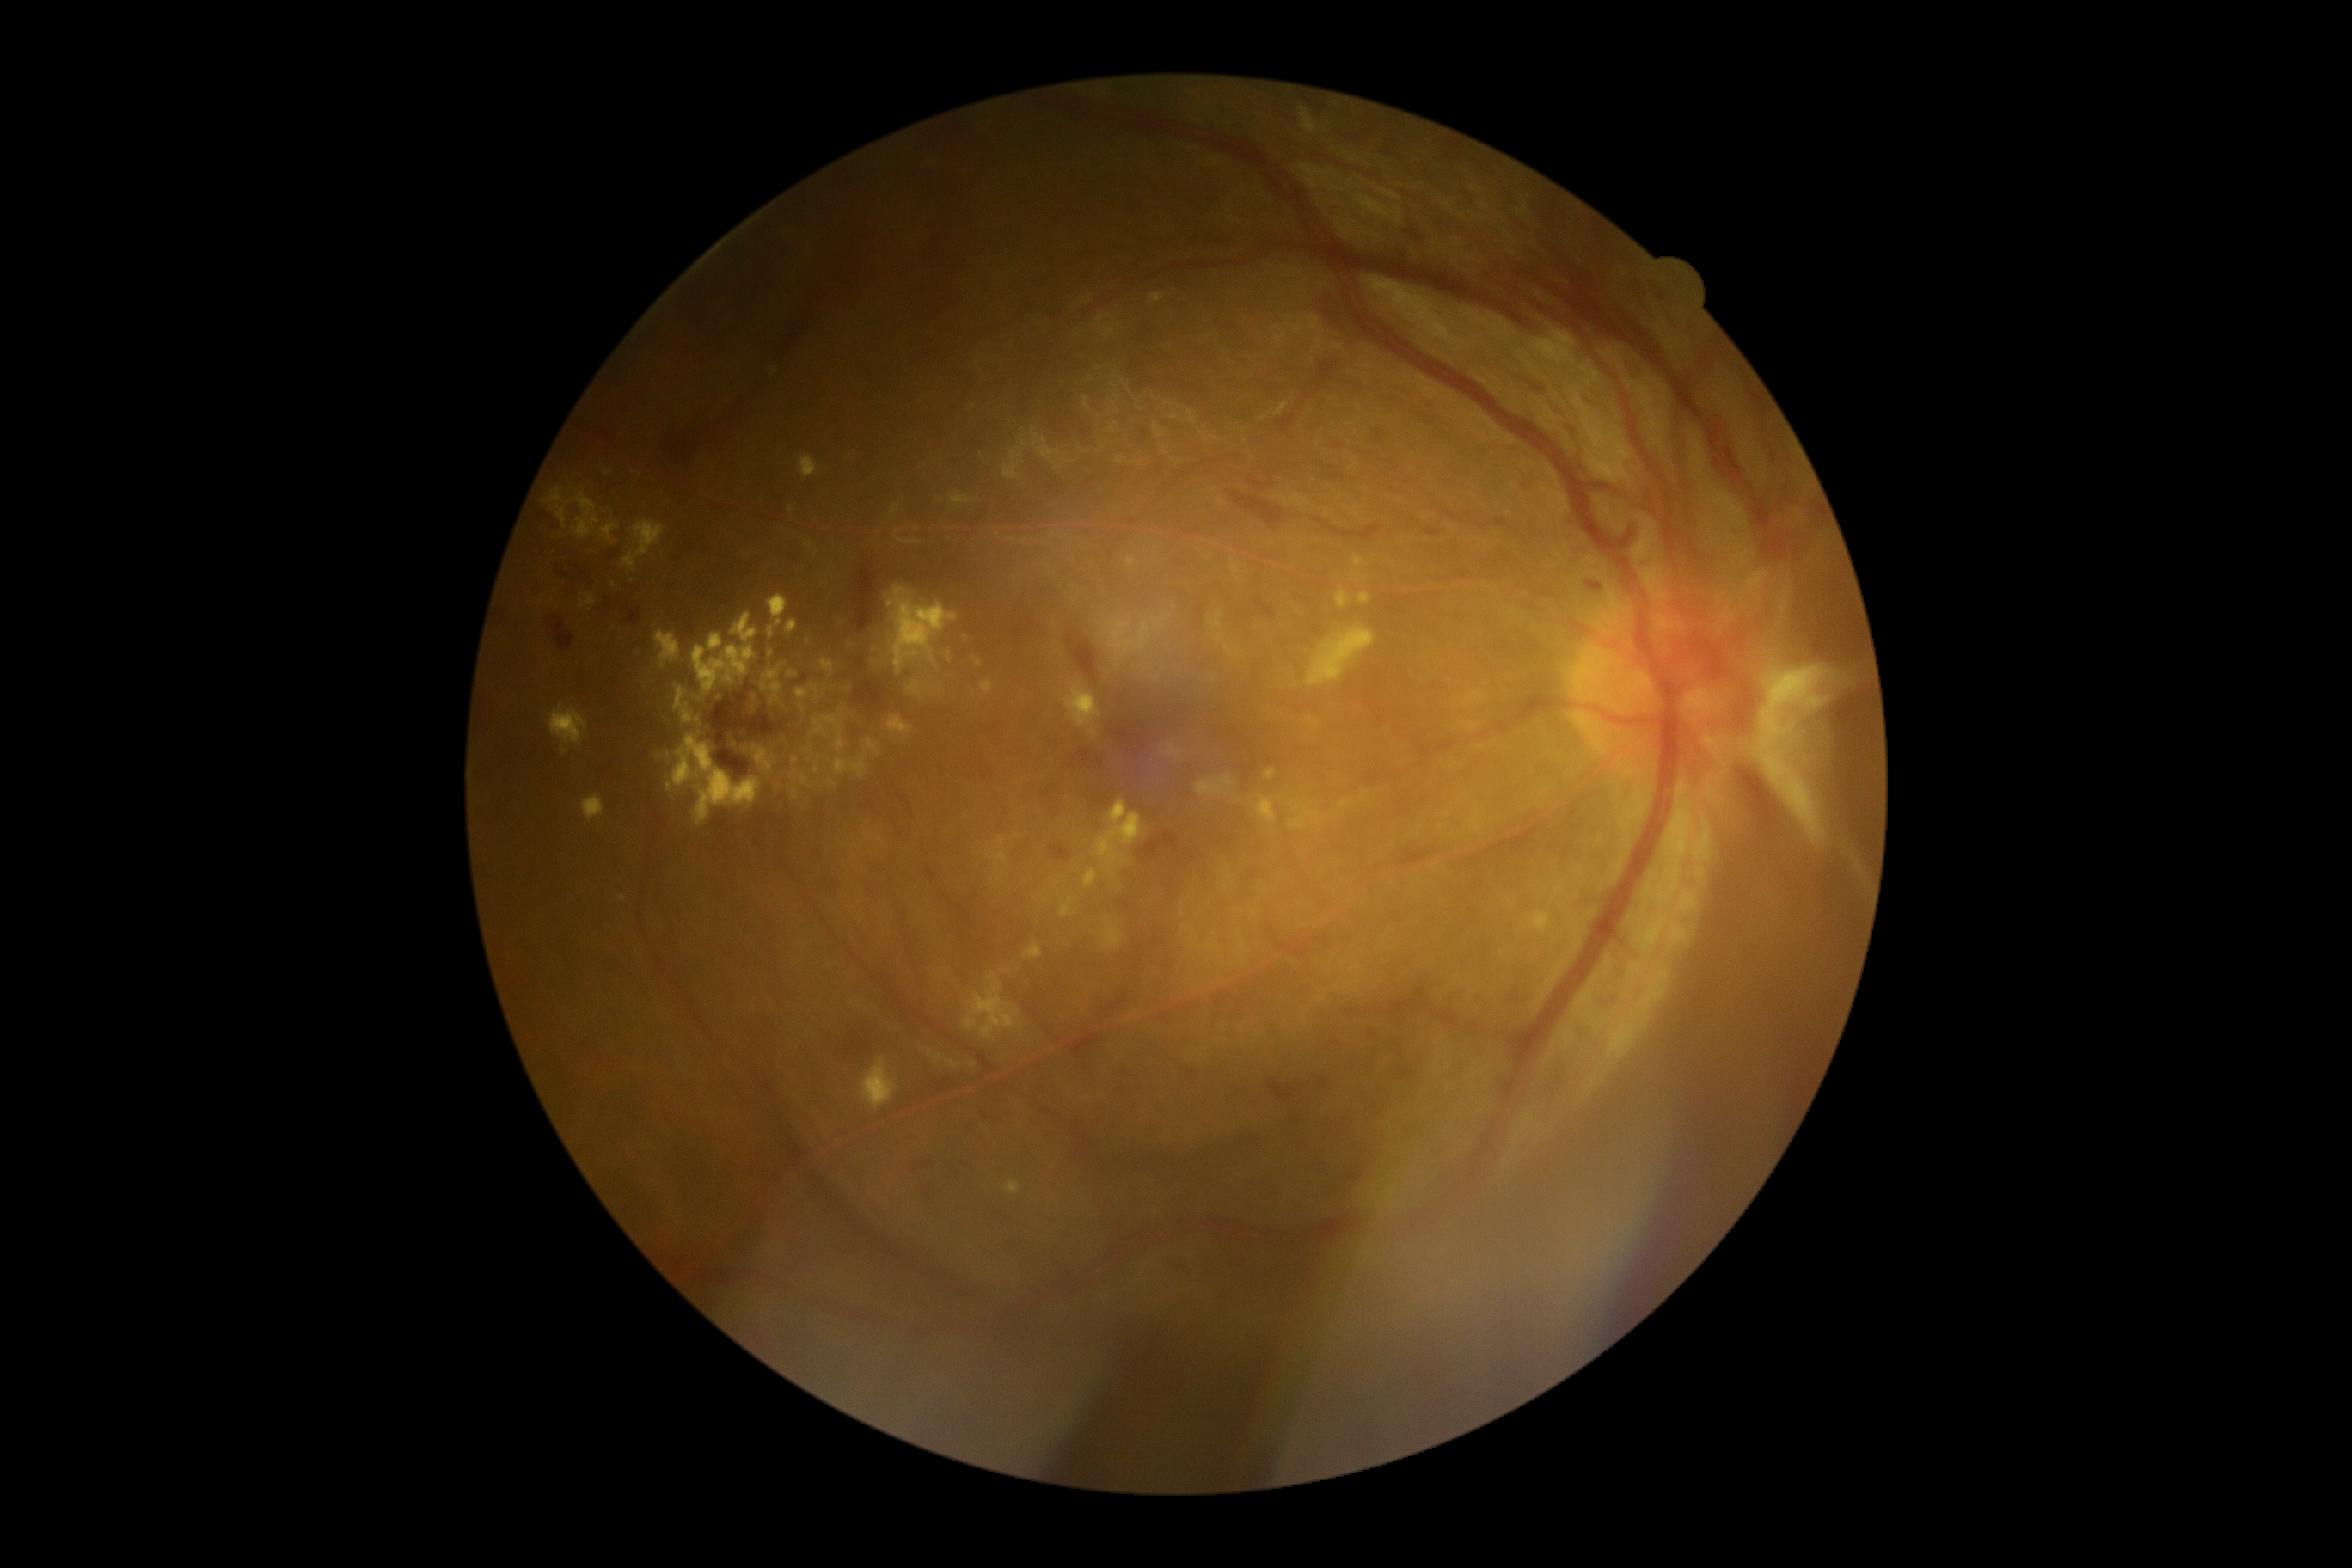

Diabetic retinopathy (DR): 4 — neovascularization and/or vitreous/pre-retinal hemorrhage
Selected lesions:
hard exudates (EXs) (partial): left=768, top=627, right=775, bottom=639; left=1127, top=814, right=1141, bottom=845; left=732, top=613, right=757, bottom=644; left=1184, top=928, right=1197, bottom=938; left=1103, top=917, right=1122, bottom=952; left=730, top=737, right=756, bottom=759; left=797, top=690, right=809, bottom=699; left=1098, top=835, right=1108, bottom=857; left=1024, top=943, right=1043, bottom=960; left=907, top=682, right=922, bottom=699; left=981, top=682, right=995, bottom=695; left=862, top=1057, right=898, bottom=1112; left=888, top=587, right=959, bottom=675
Additional small EXs near (614; 585); (844; 709); (609; 472); (824; 695); (772; 653)
hemorrhages (HEs) (partial): left=1373, top=429, right=1387, bottom=443; left=1407, top=230, right=1421, bottom=240; left=960, top=907, right=972, bottom=926; left=1399, top=1063, right=1416, bottom=1081; left=1179, top=1063, right=1199, bottom=1079; left=1141, top=831, right=1177, bottom=861; left=855, top=678, right=883, bottom=706; left=854, top=563, right=876, bottom=634; left=1404, top=1124, right=1418, bottom=1136; left=1163, top=1259, right=1194, bottom=1273; left=499, top=613, right=505, bottom=628; left=1079, top=749, right=1105, bottom=769; left=855, top=658, right=866, bottom=670; left=1320, top=1077, right=1330, bottom=1087; left=711, top=695, right=787, bottom=778
Additional small HEs near (747; 688); (1517; 998)